NIDEK AFC-230
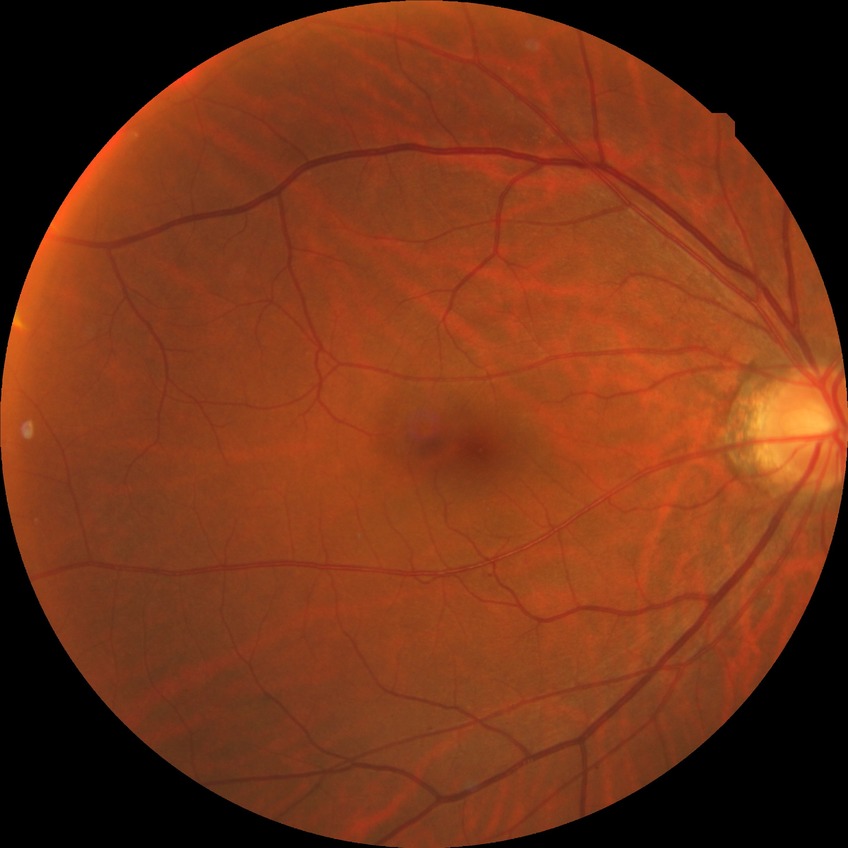

davis_grade: simple diabetic retinopathy